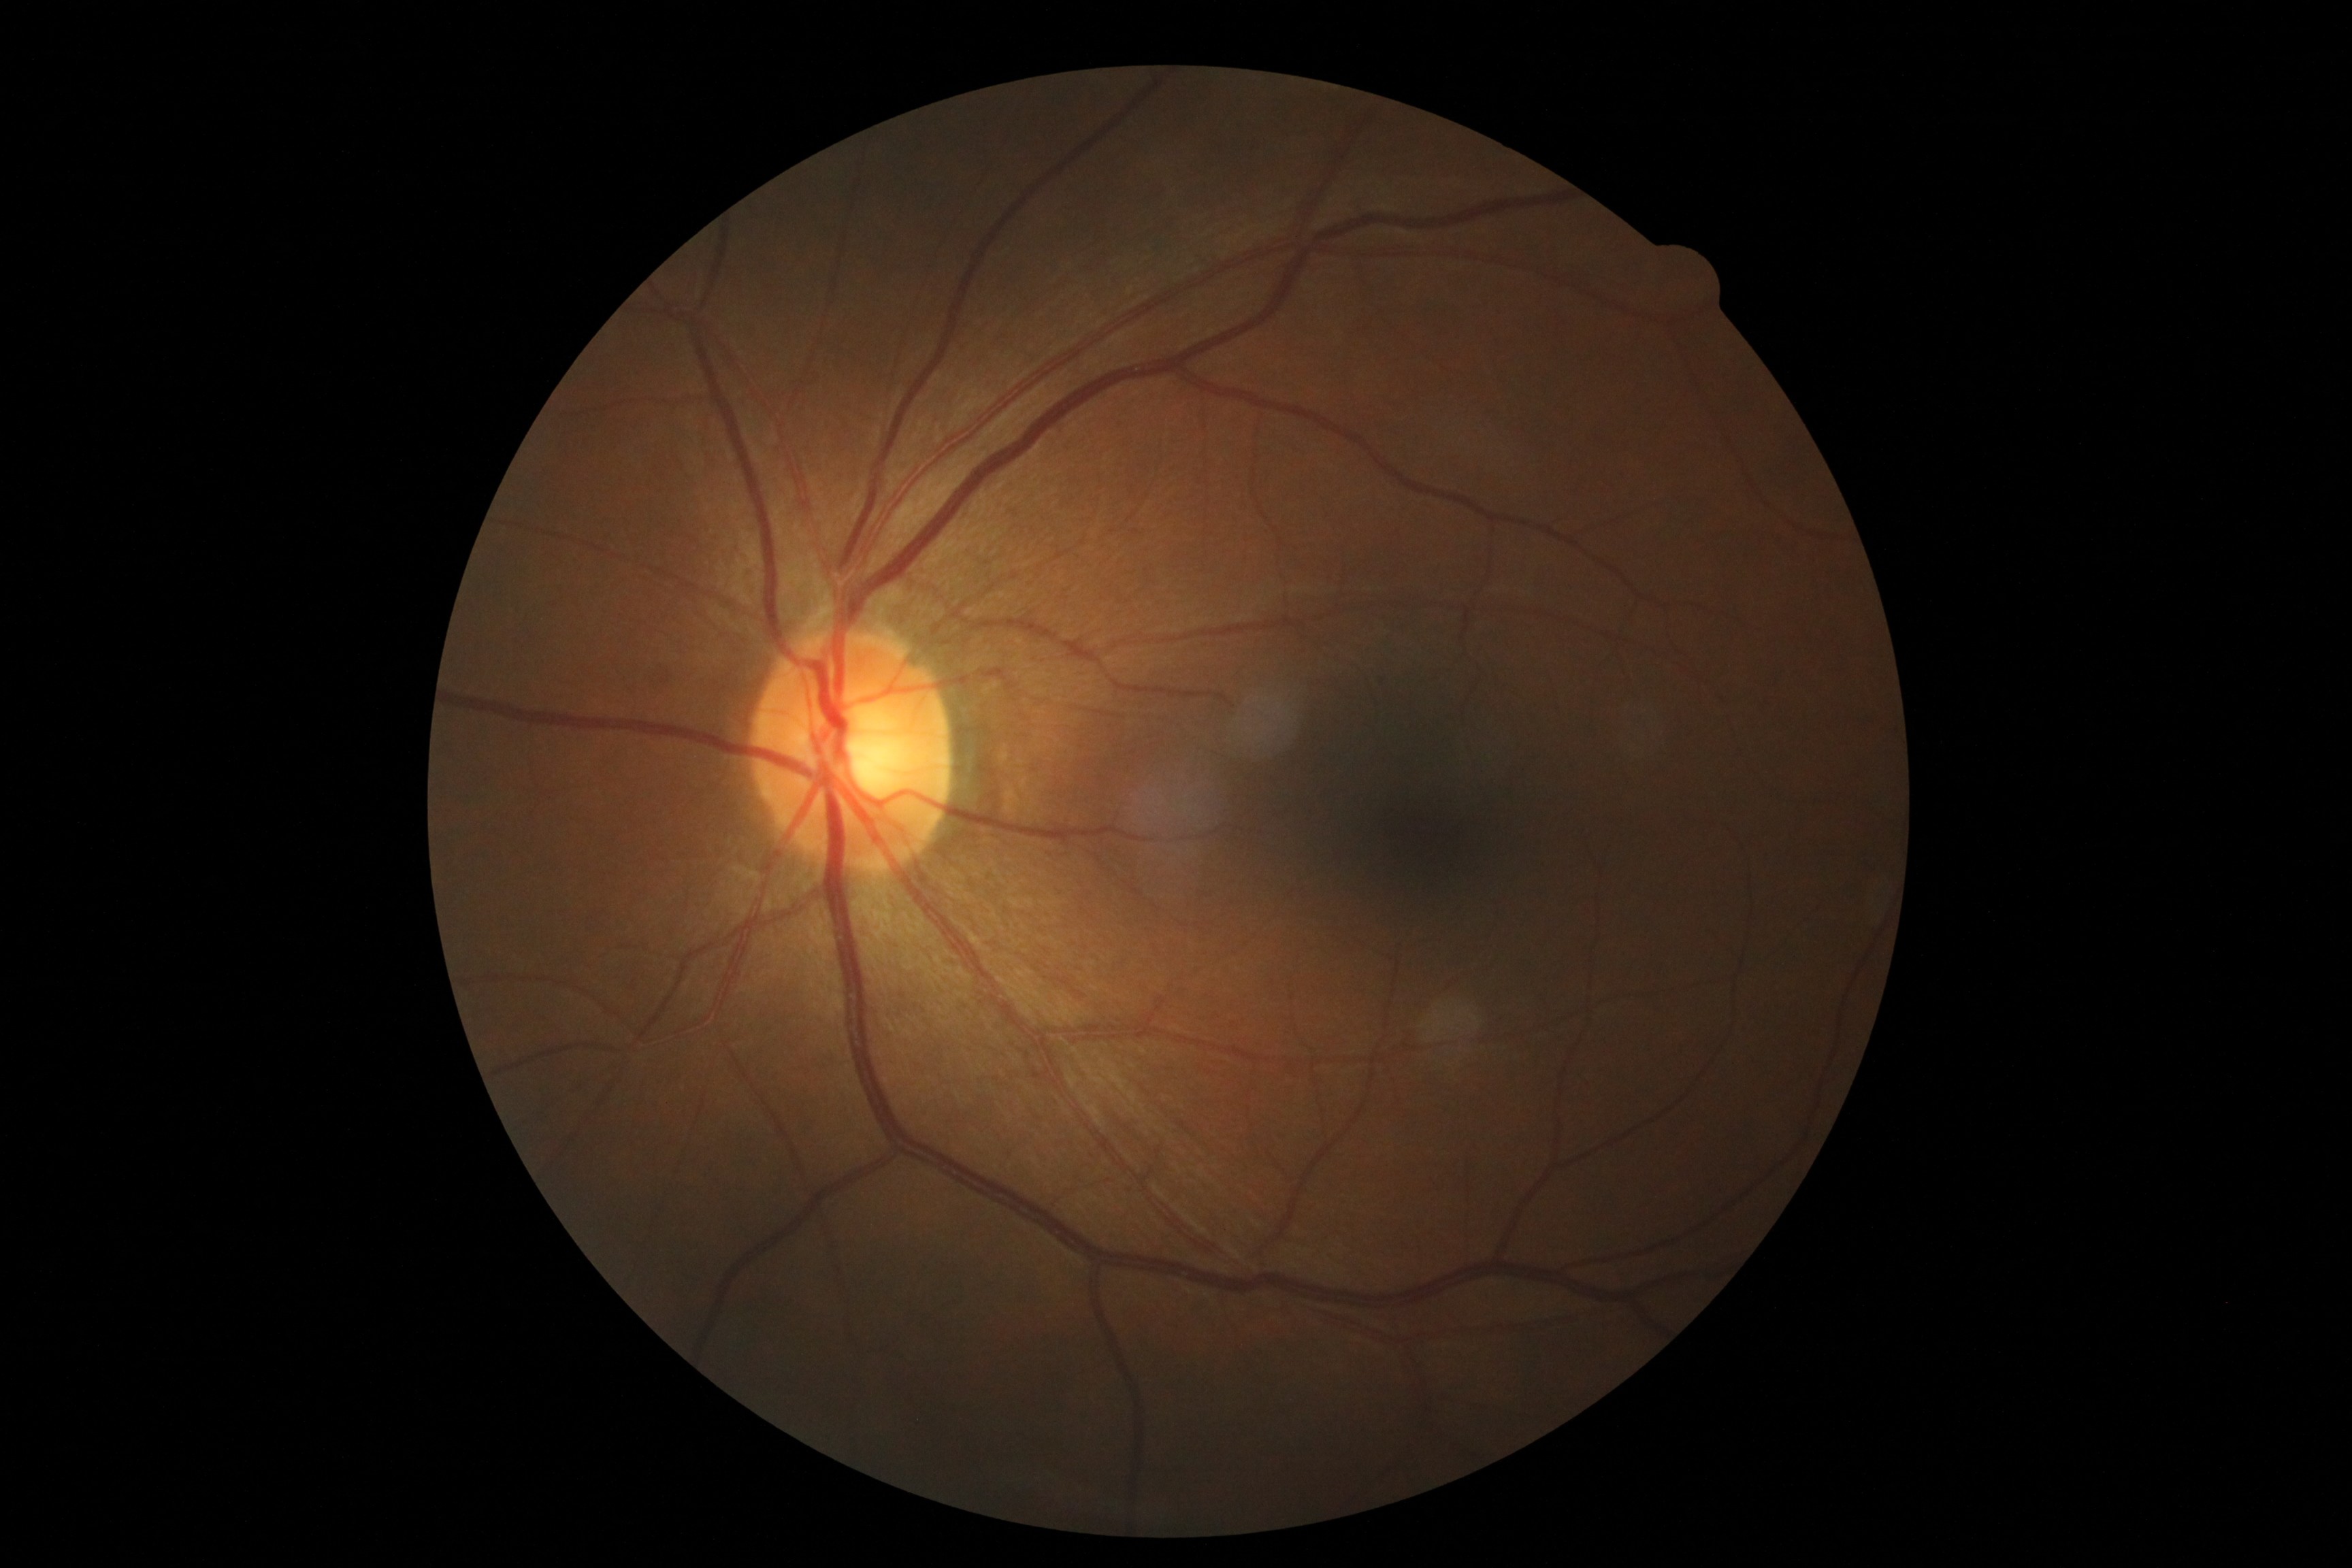
{"dr_grade": "0 (no apparent retinopathy)"}